Captured with the Clarity RetCam 3 (130° field of view) · infant wide-field retinal image: 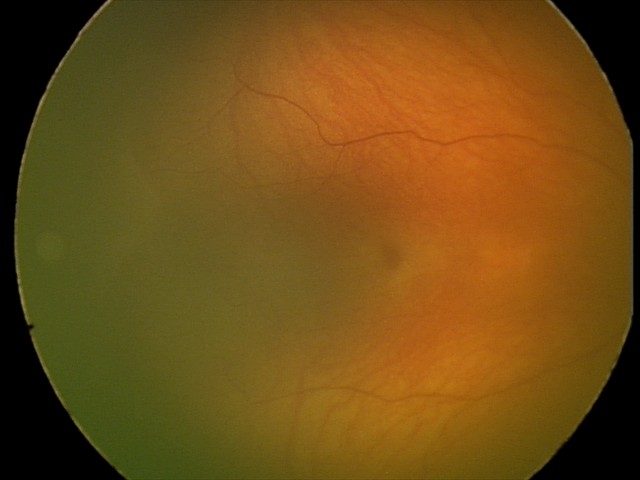

Screening series with retinopathy of prematurity (ROP) stage 1 — demarcation line between vascular and avascular retina.